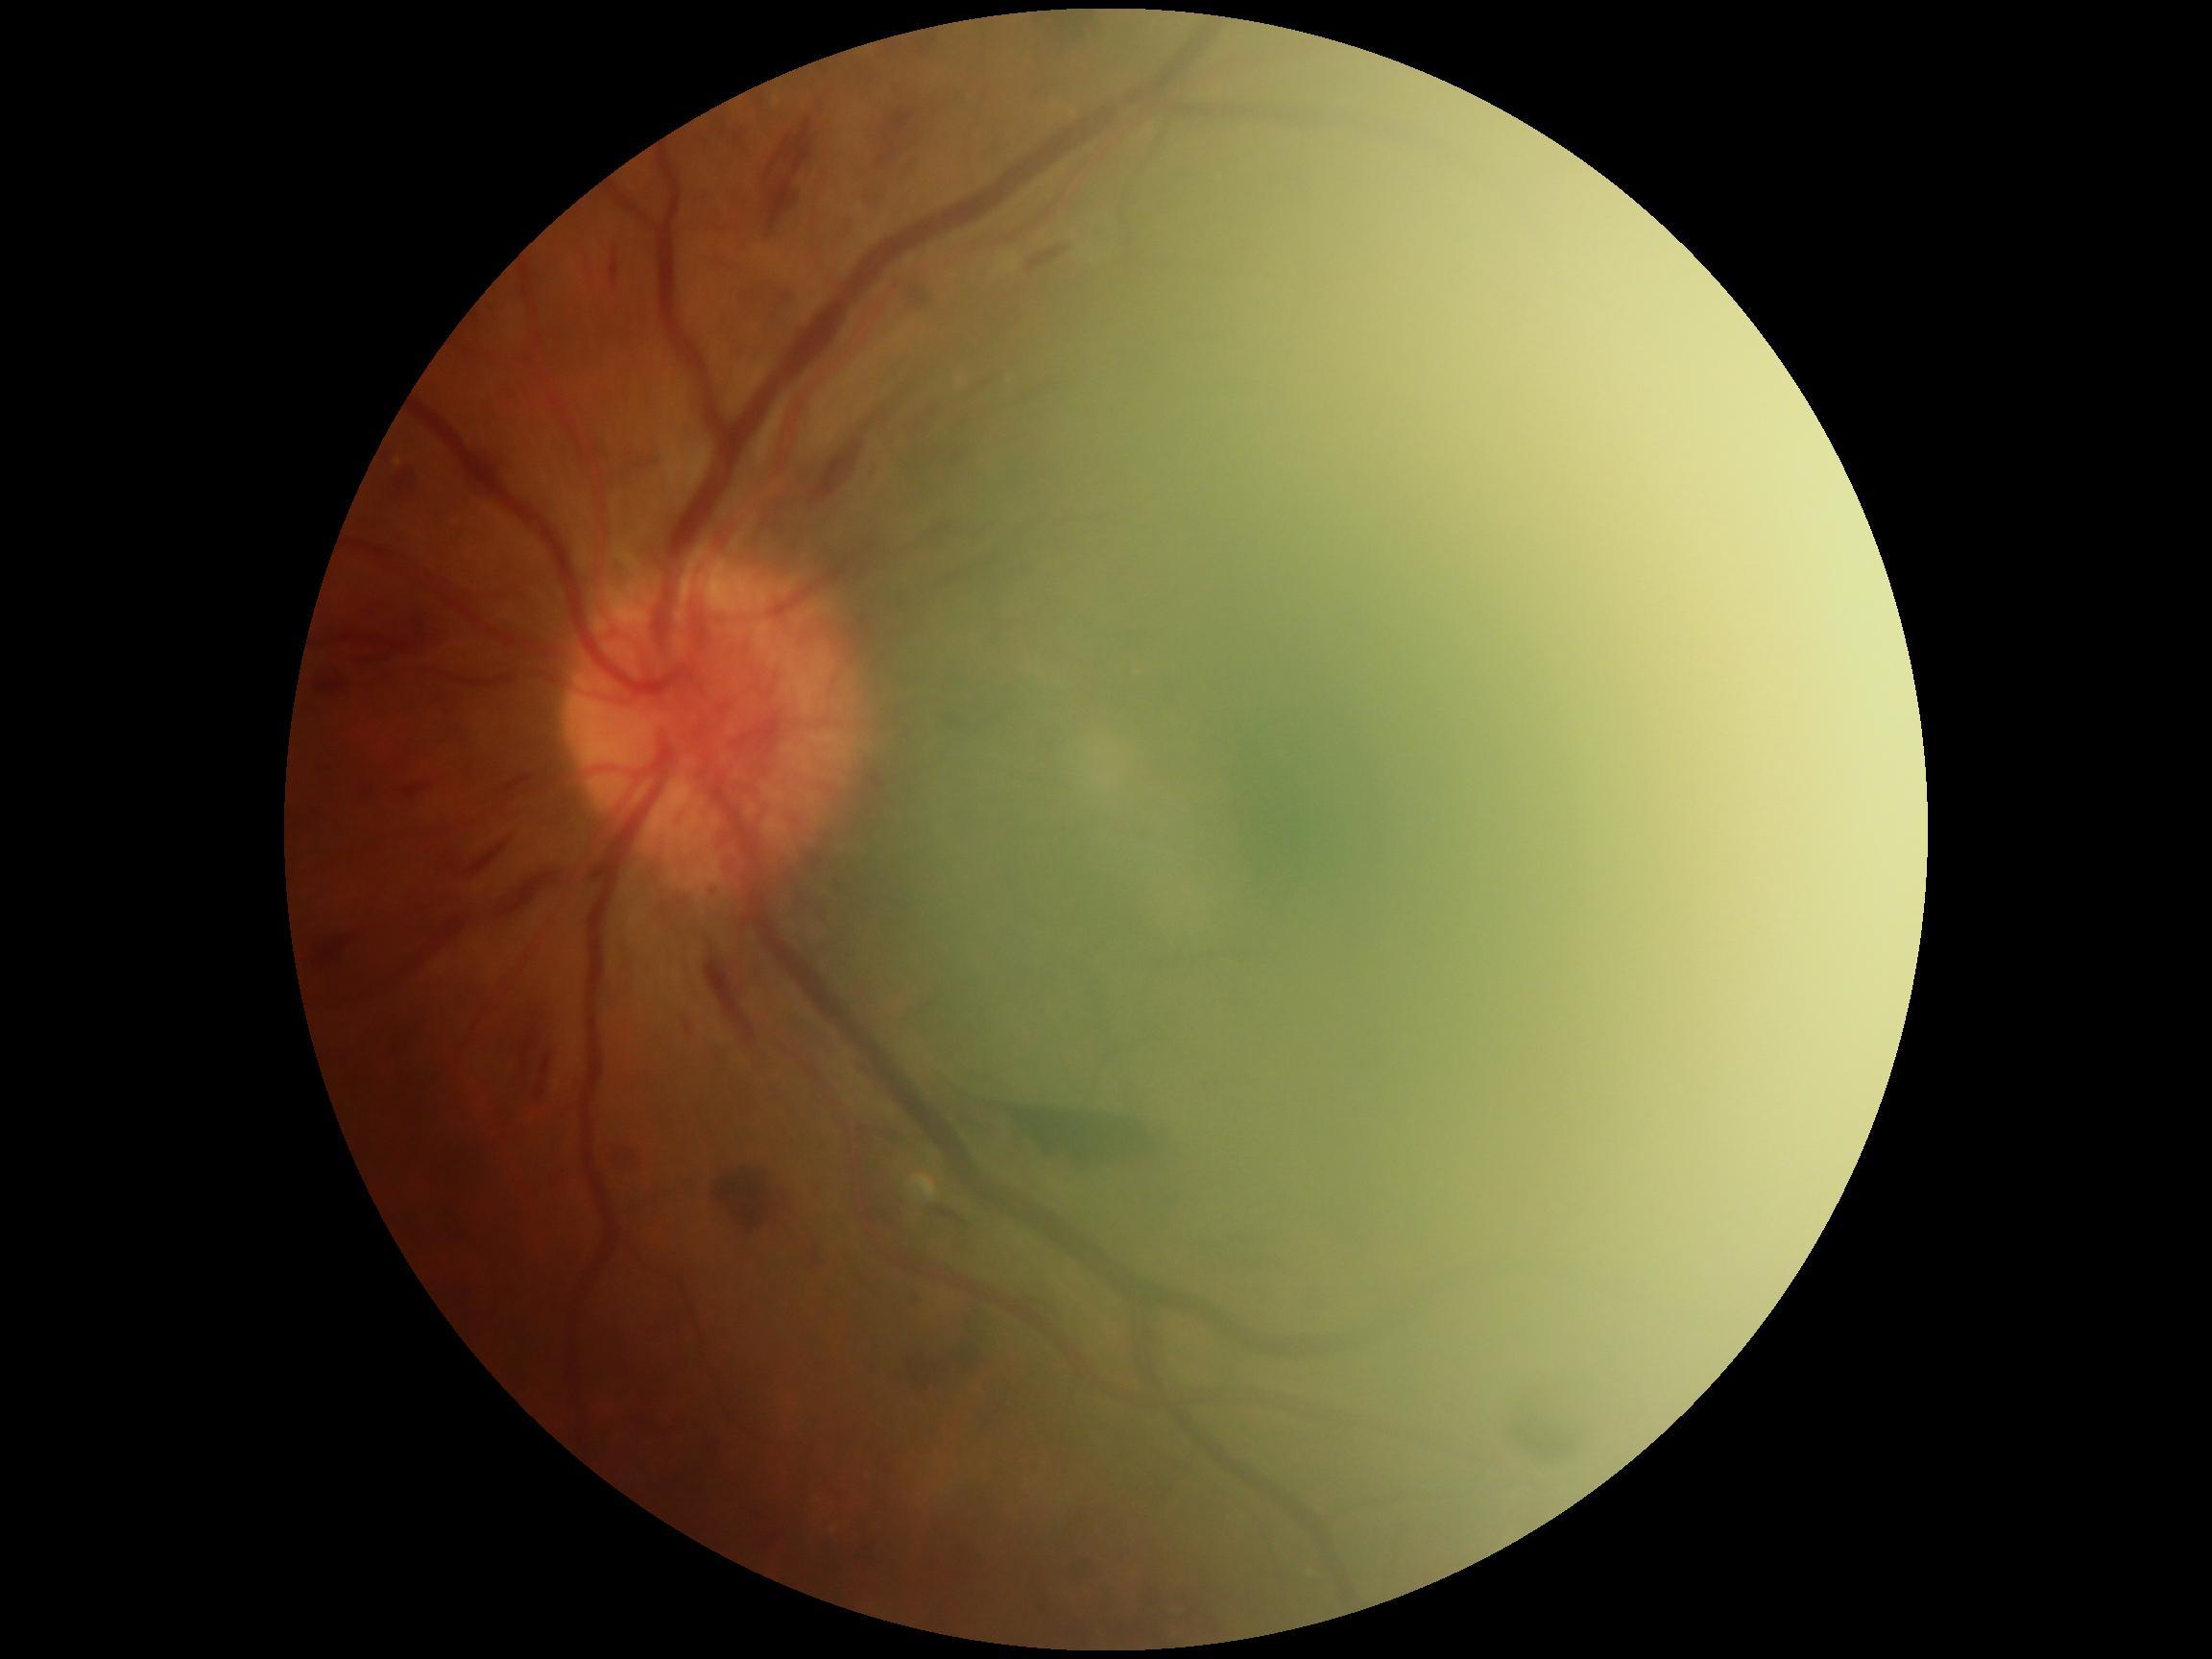 Annotations:
– DR stage — grade 4 (PDR)